2352x1568: 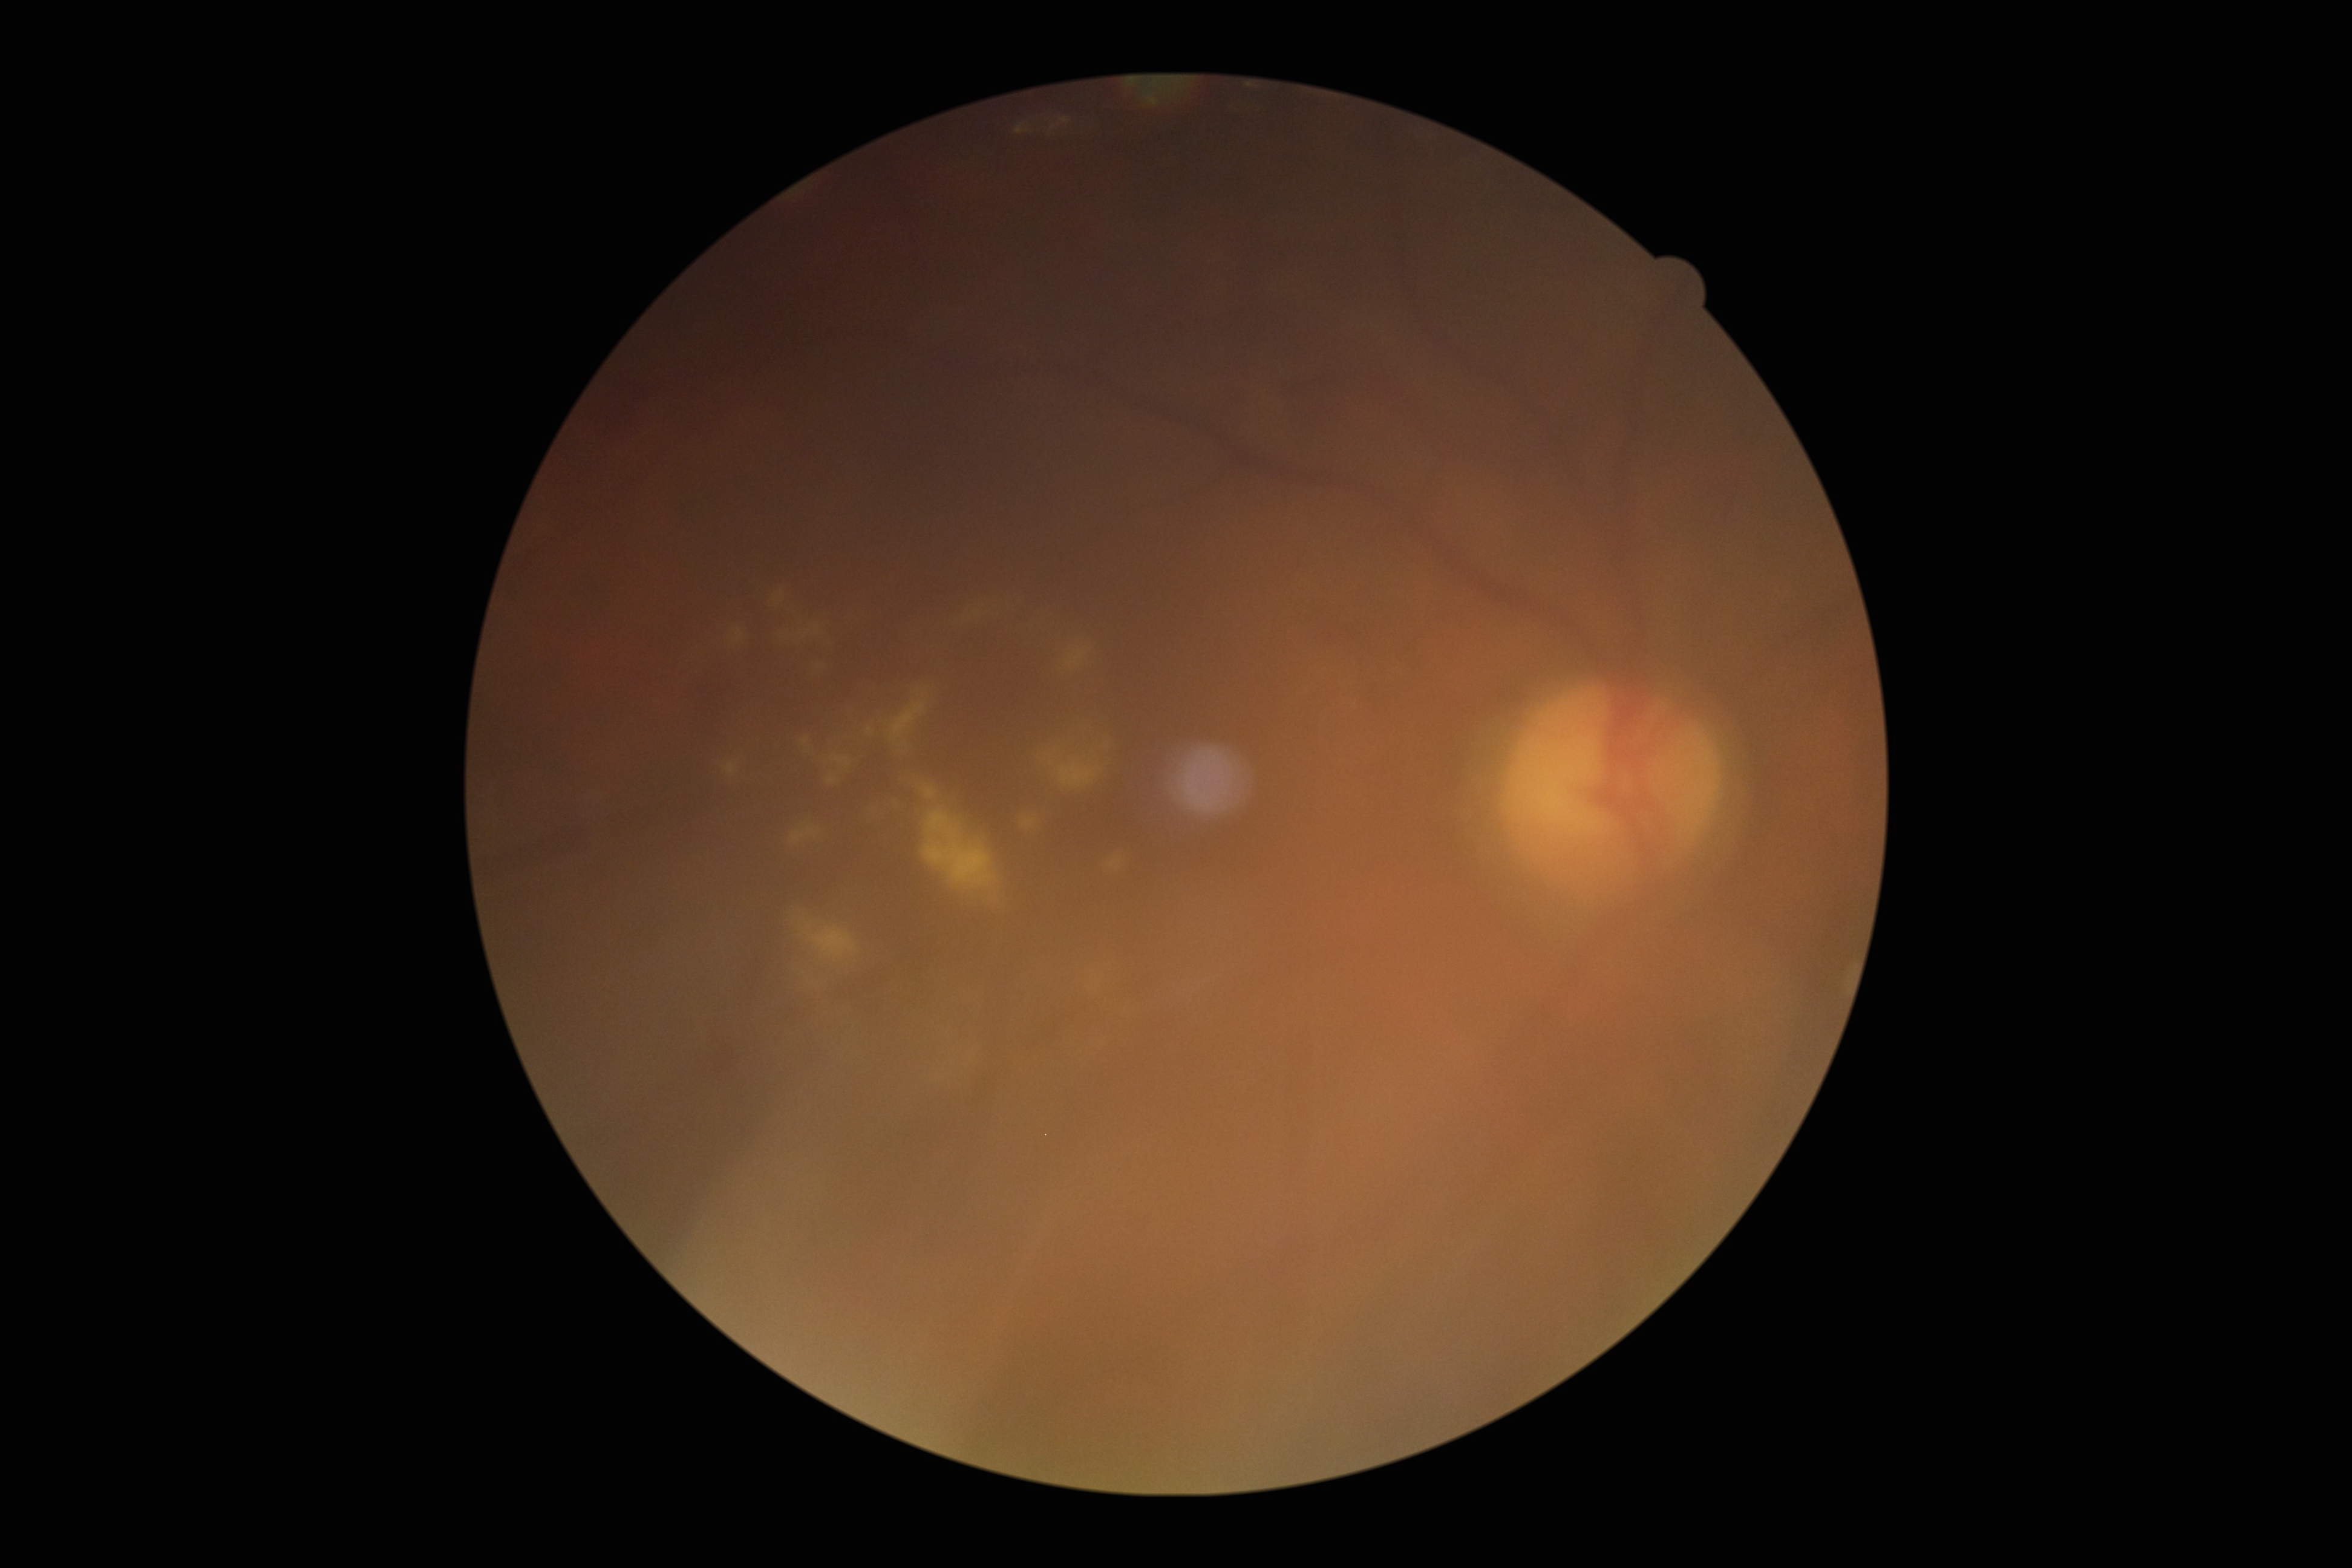
Diabetic retinopathy grade is 2 — more than just microaneurysms but less than severe NPDR.